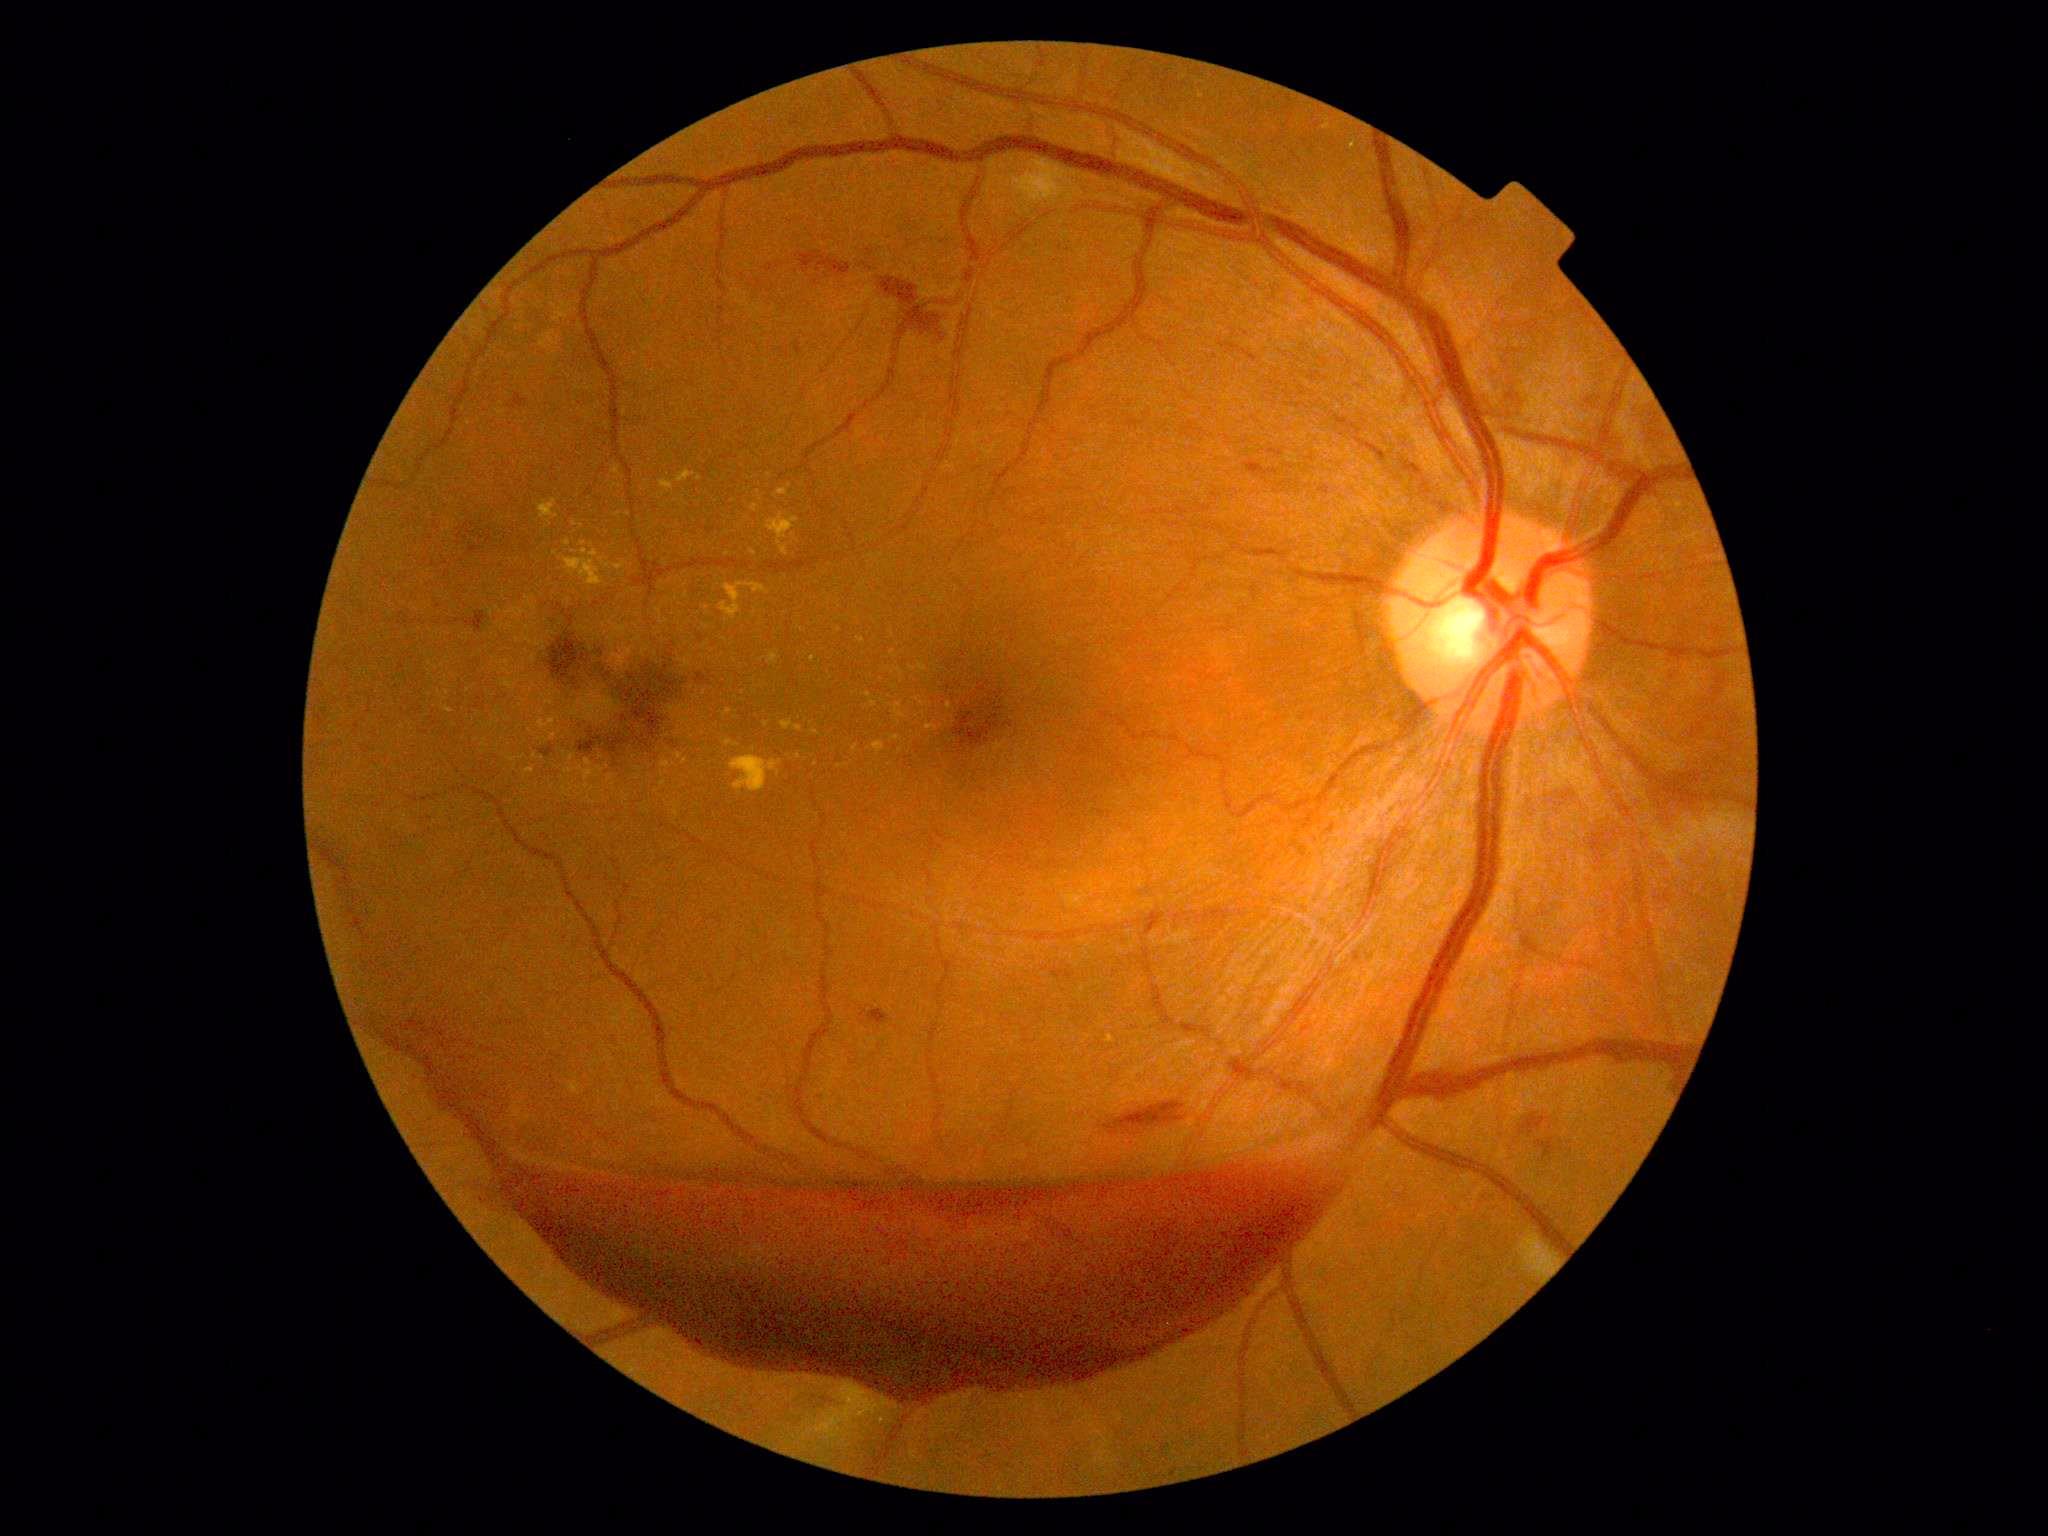

DR severity is grade 4 — neovascularization and/or vitreous/pre-retinal hemorrhage
Selected lesions:
EXs (subset): (x1=563, y1=549, x2=605, y2=586) | (x1=509, y1=758, x2=518, y2=762) | (x1=891, y1=650, x2=898, y2=658) | (x1=1107, y1=1035, x2=1115, y2=1044) | (x1=781, y1=720, x2=802, y2=732) | (x1=539, y1=720, x2=556, y2=730) | (x1=569, y1=785, x2=575, y2=793) | (x1=1350, y1=139, x2=1357, y2=151) | (x1=775, y1=489, x2=788, y2=498)
Small EXs near Point(468, 690) | Point(816, 765) | Point(685, 585) | Point(663, 783) | Point(761, 499) | Point(671, 581) | Point(686, 596) | Point(901, 751) | Point(535, 757)